Posterior pole photograph; 848 by 848 pixels: 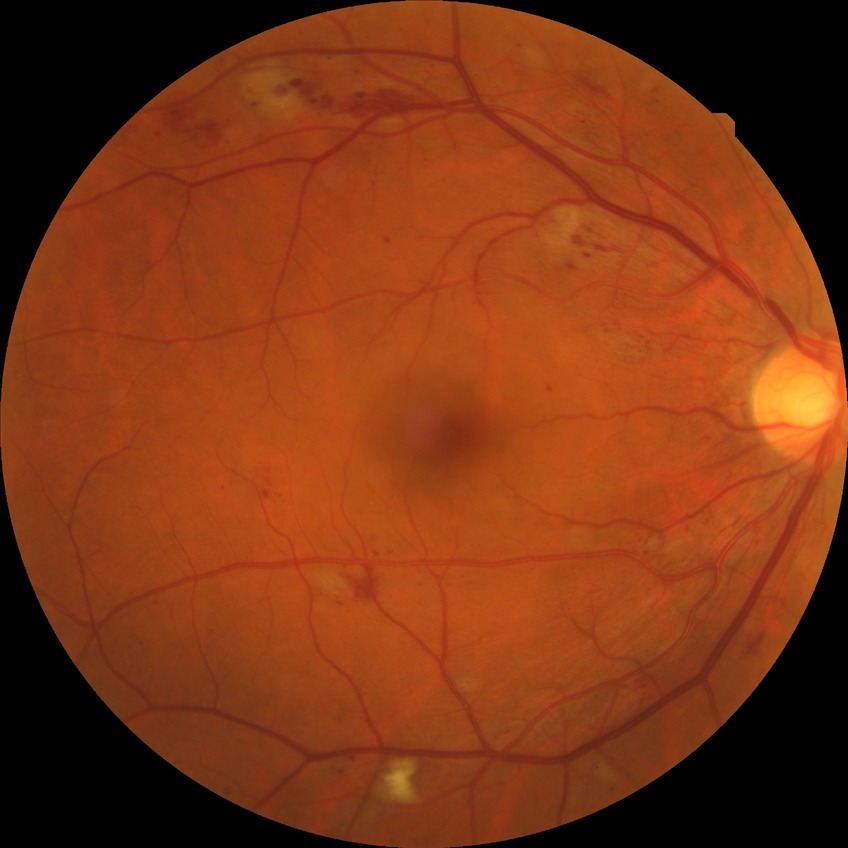

Diabetic retinopathy (DR) is PPDR (pre-proliferative diabetic retinopathy).